848 x 848 pixels.
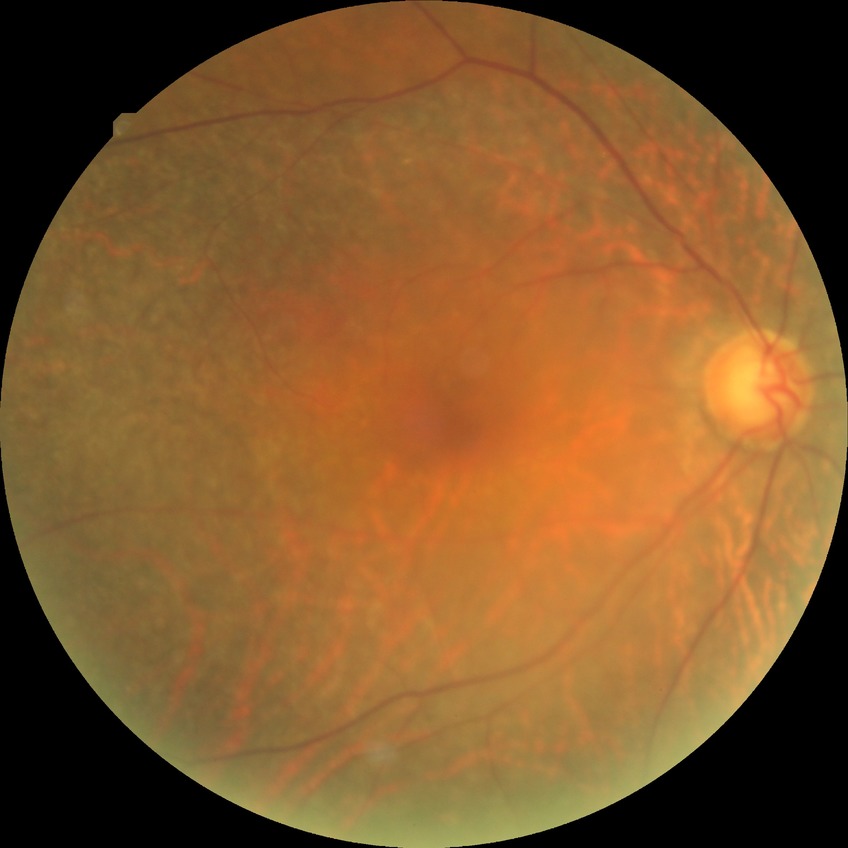

{"dr_impression": "no signs of DR", "davis_grade": "NDR"}